45° field of view · fundus photo · image size 1725x1721.
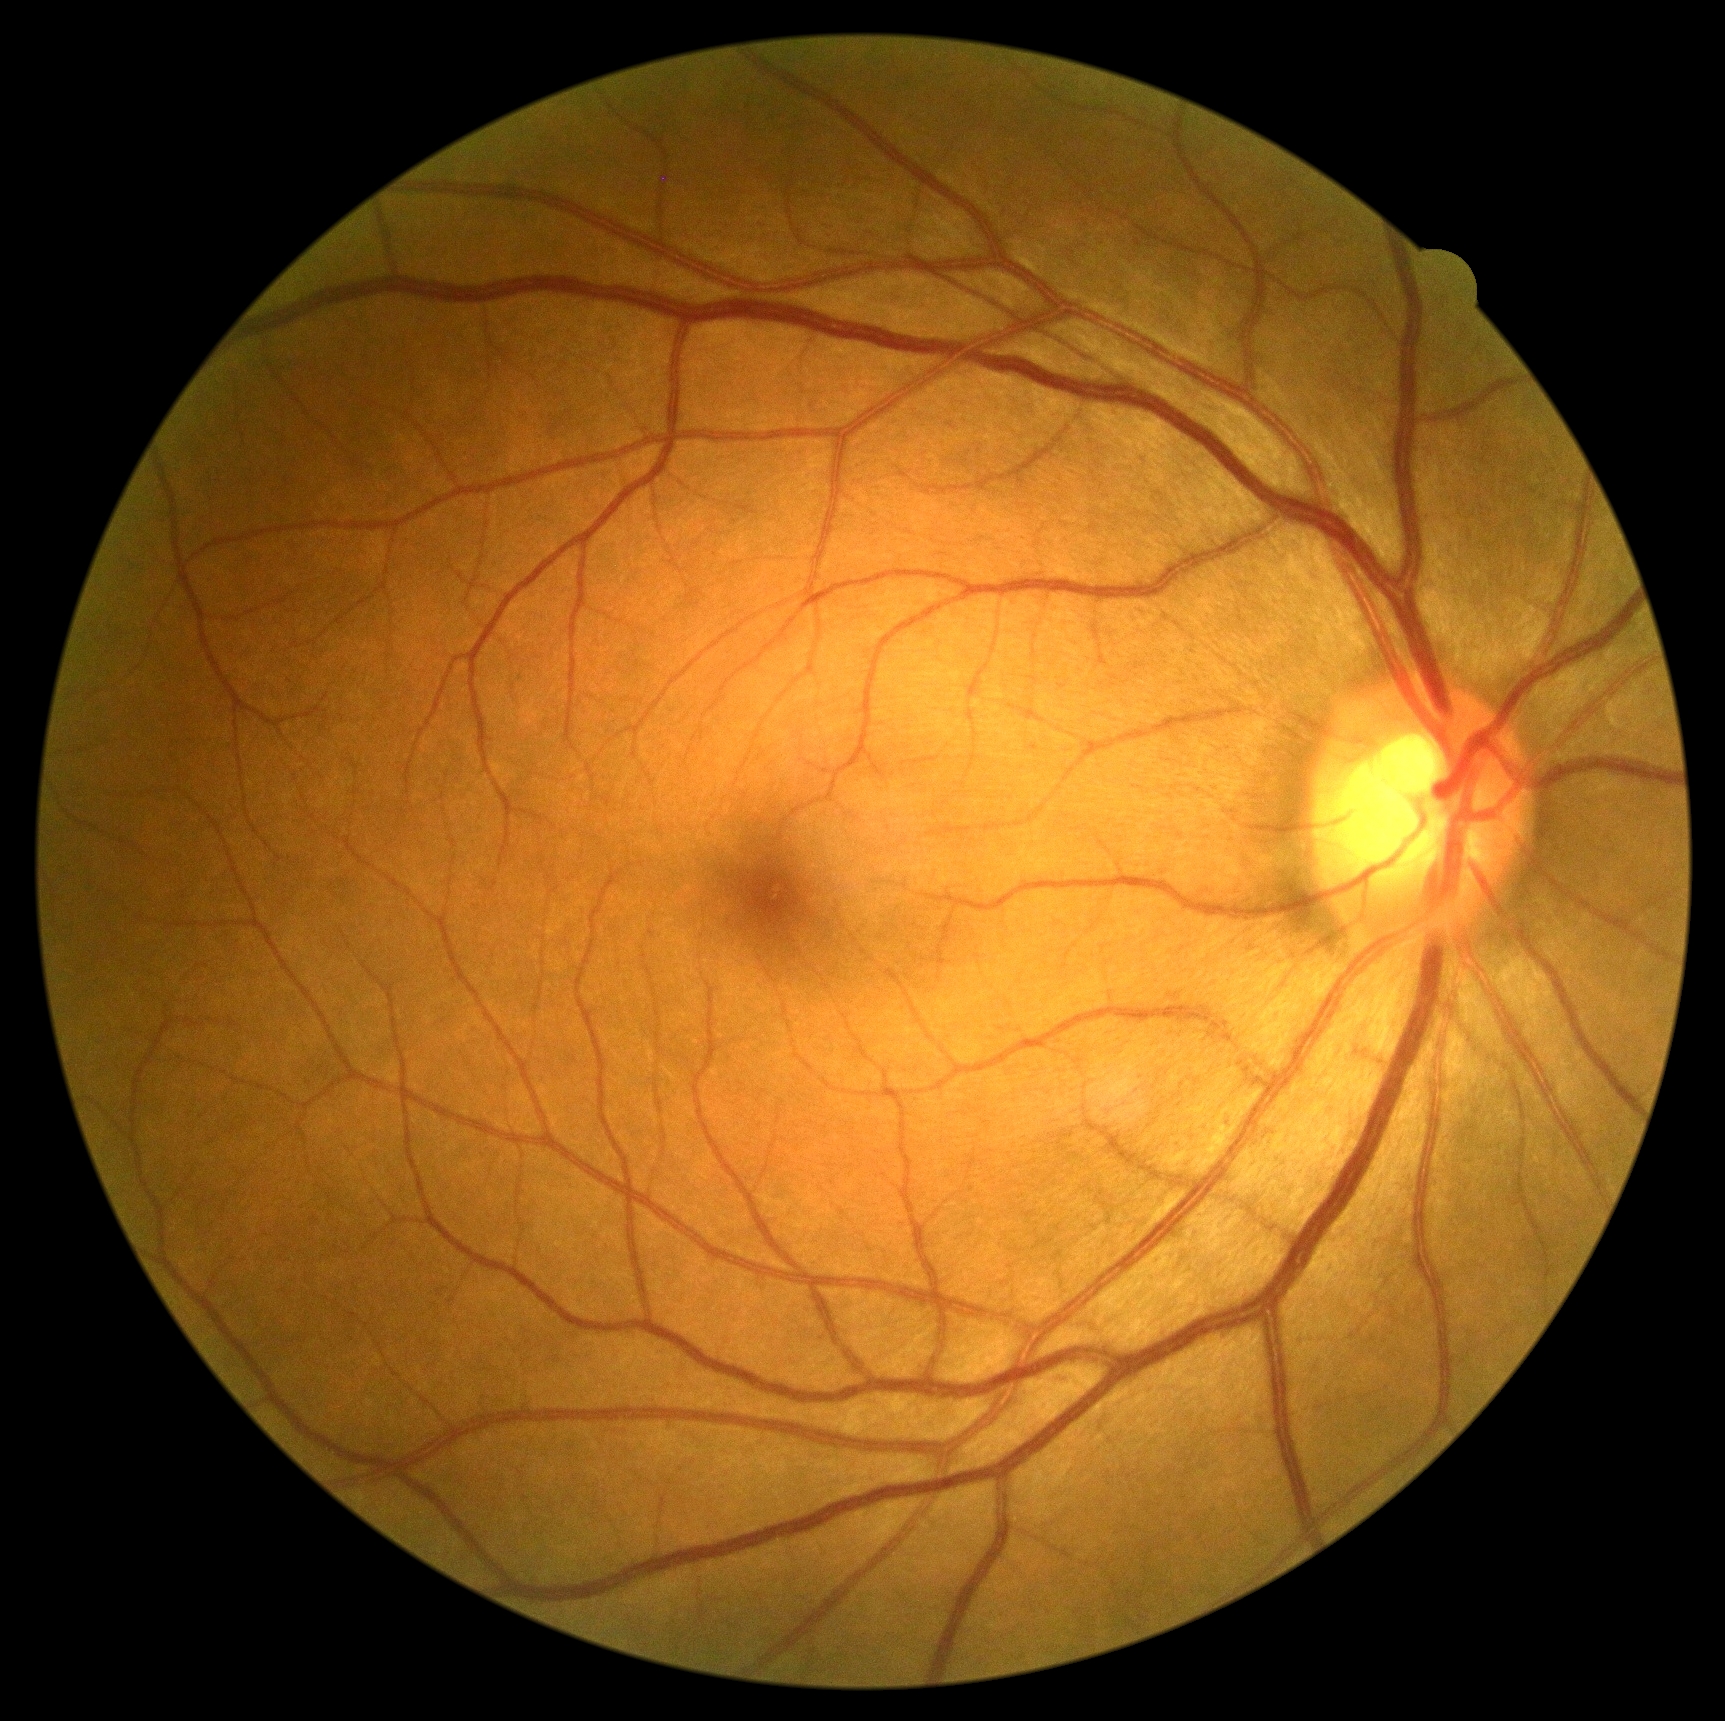 DR grade: 0 (no apparent retinopathy).
No signs of diabetic retinopathy.